Wide-field contact fundus photograph of an infant. Captured with the Clarity RetCam 3 (130° field of view)
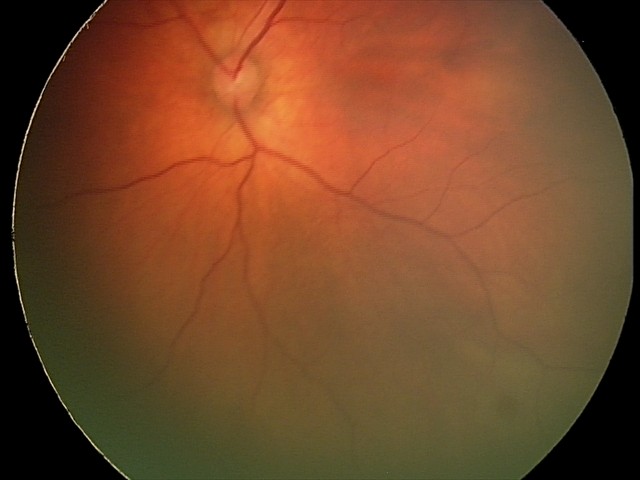
Diagnosis from this screening exam: retinal hemorrhages.